NIDEK AFC-230 · 45° FOV · modified Davis classification: 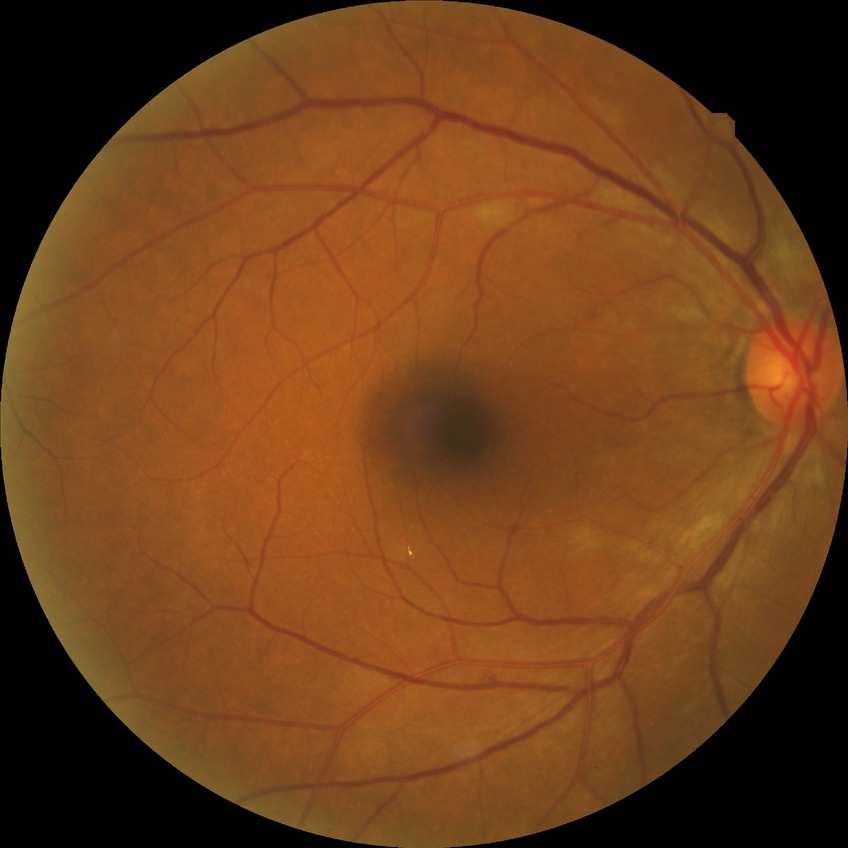

retinopathy grade@no diabetic retinopathy.